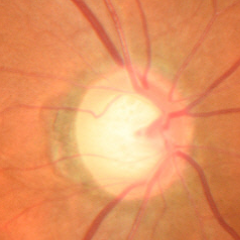

Findings consistent with glaucoma. Showing early glaucomatous optic neuropathy.